NIDEK AFC-230, color fundus image, 45-degree field of view, no pharmacologic dilation, 848 by 848 pixels
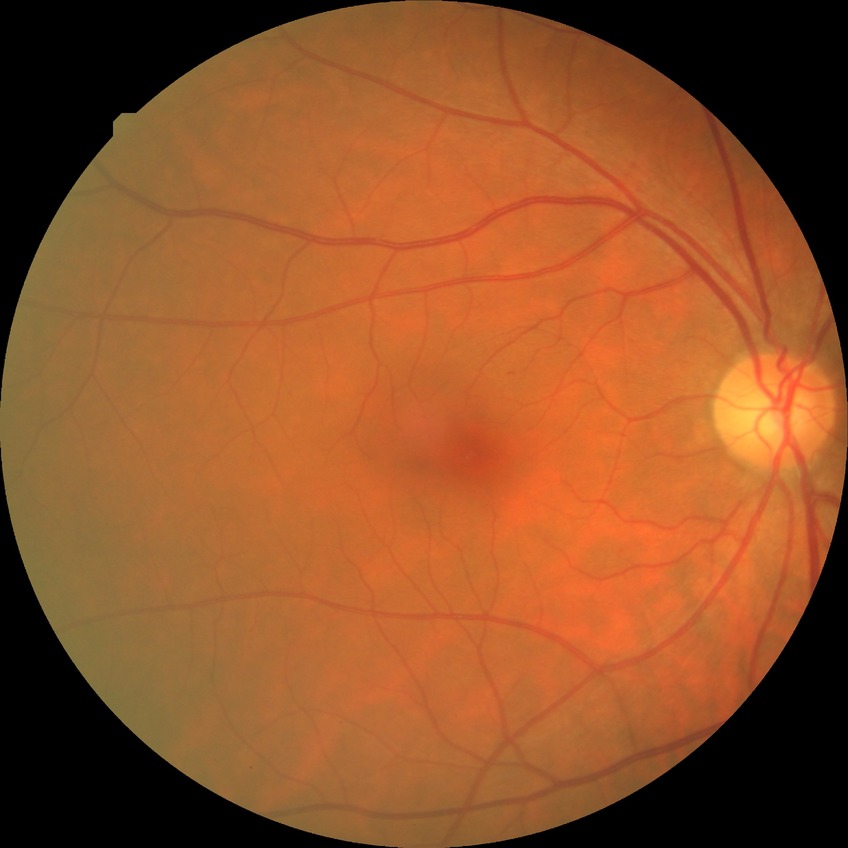 Diabetic retinopathy (DR): no diabetic retinopathy (NDR).